45° field of view — 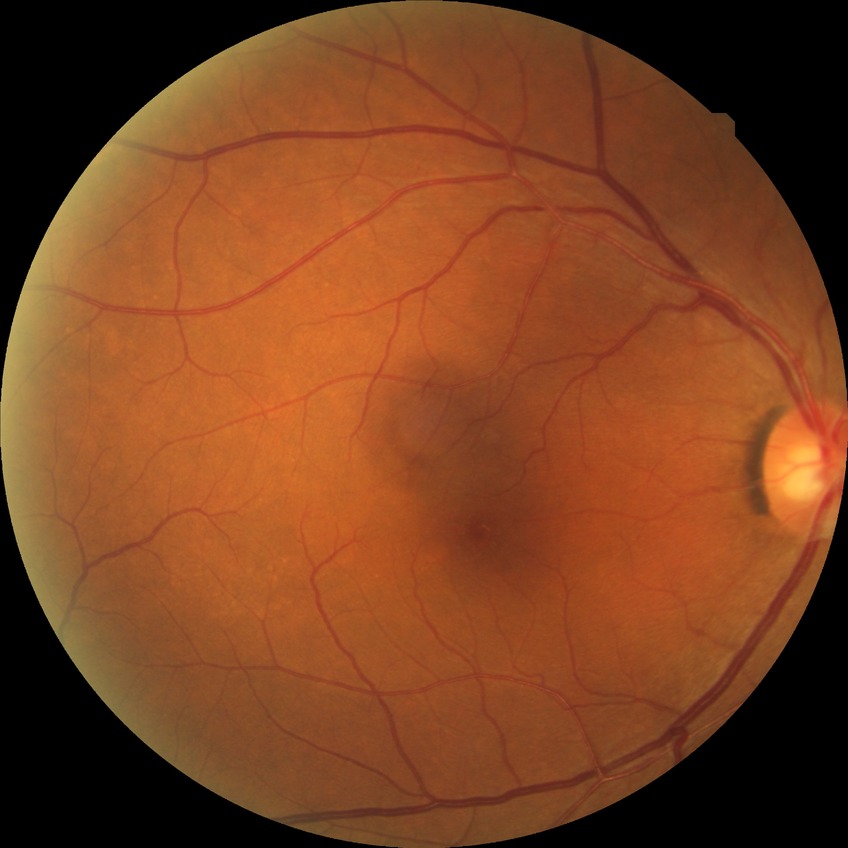
Modified Davis grade: NDR. No diabetic retinal disease findings.